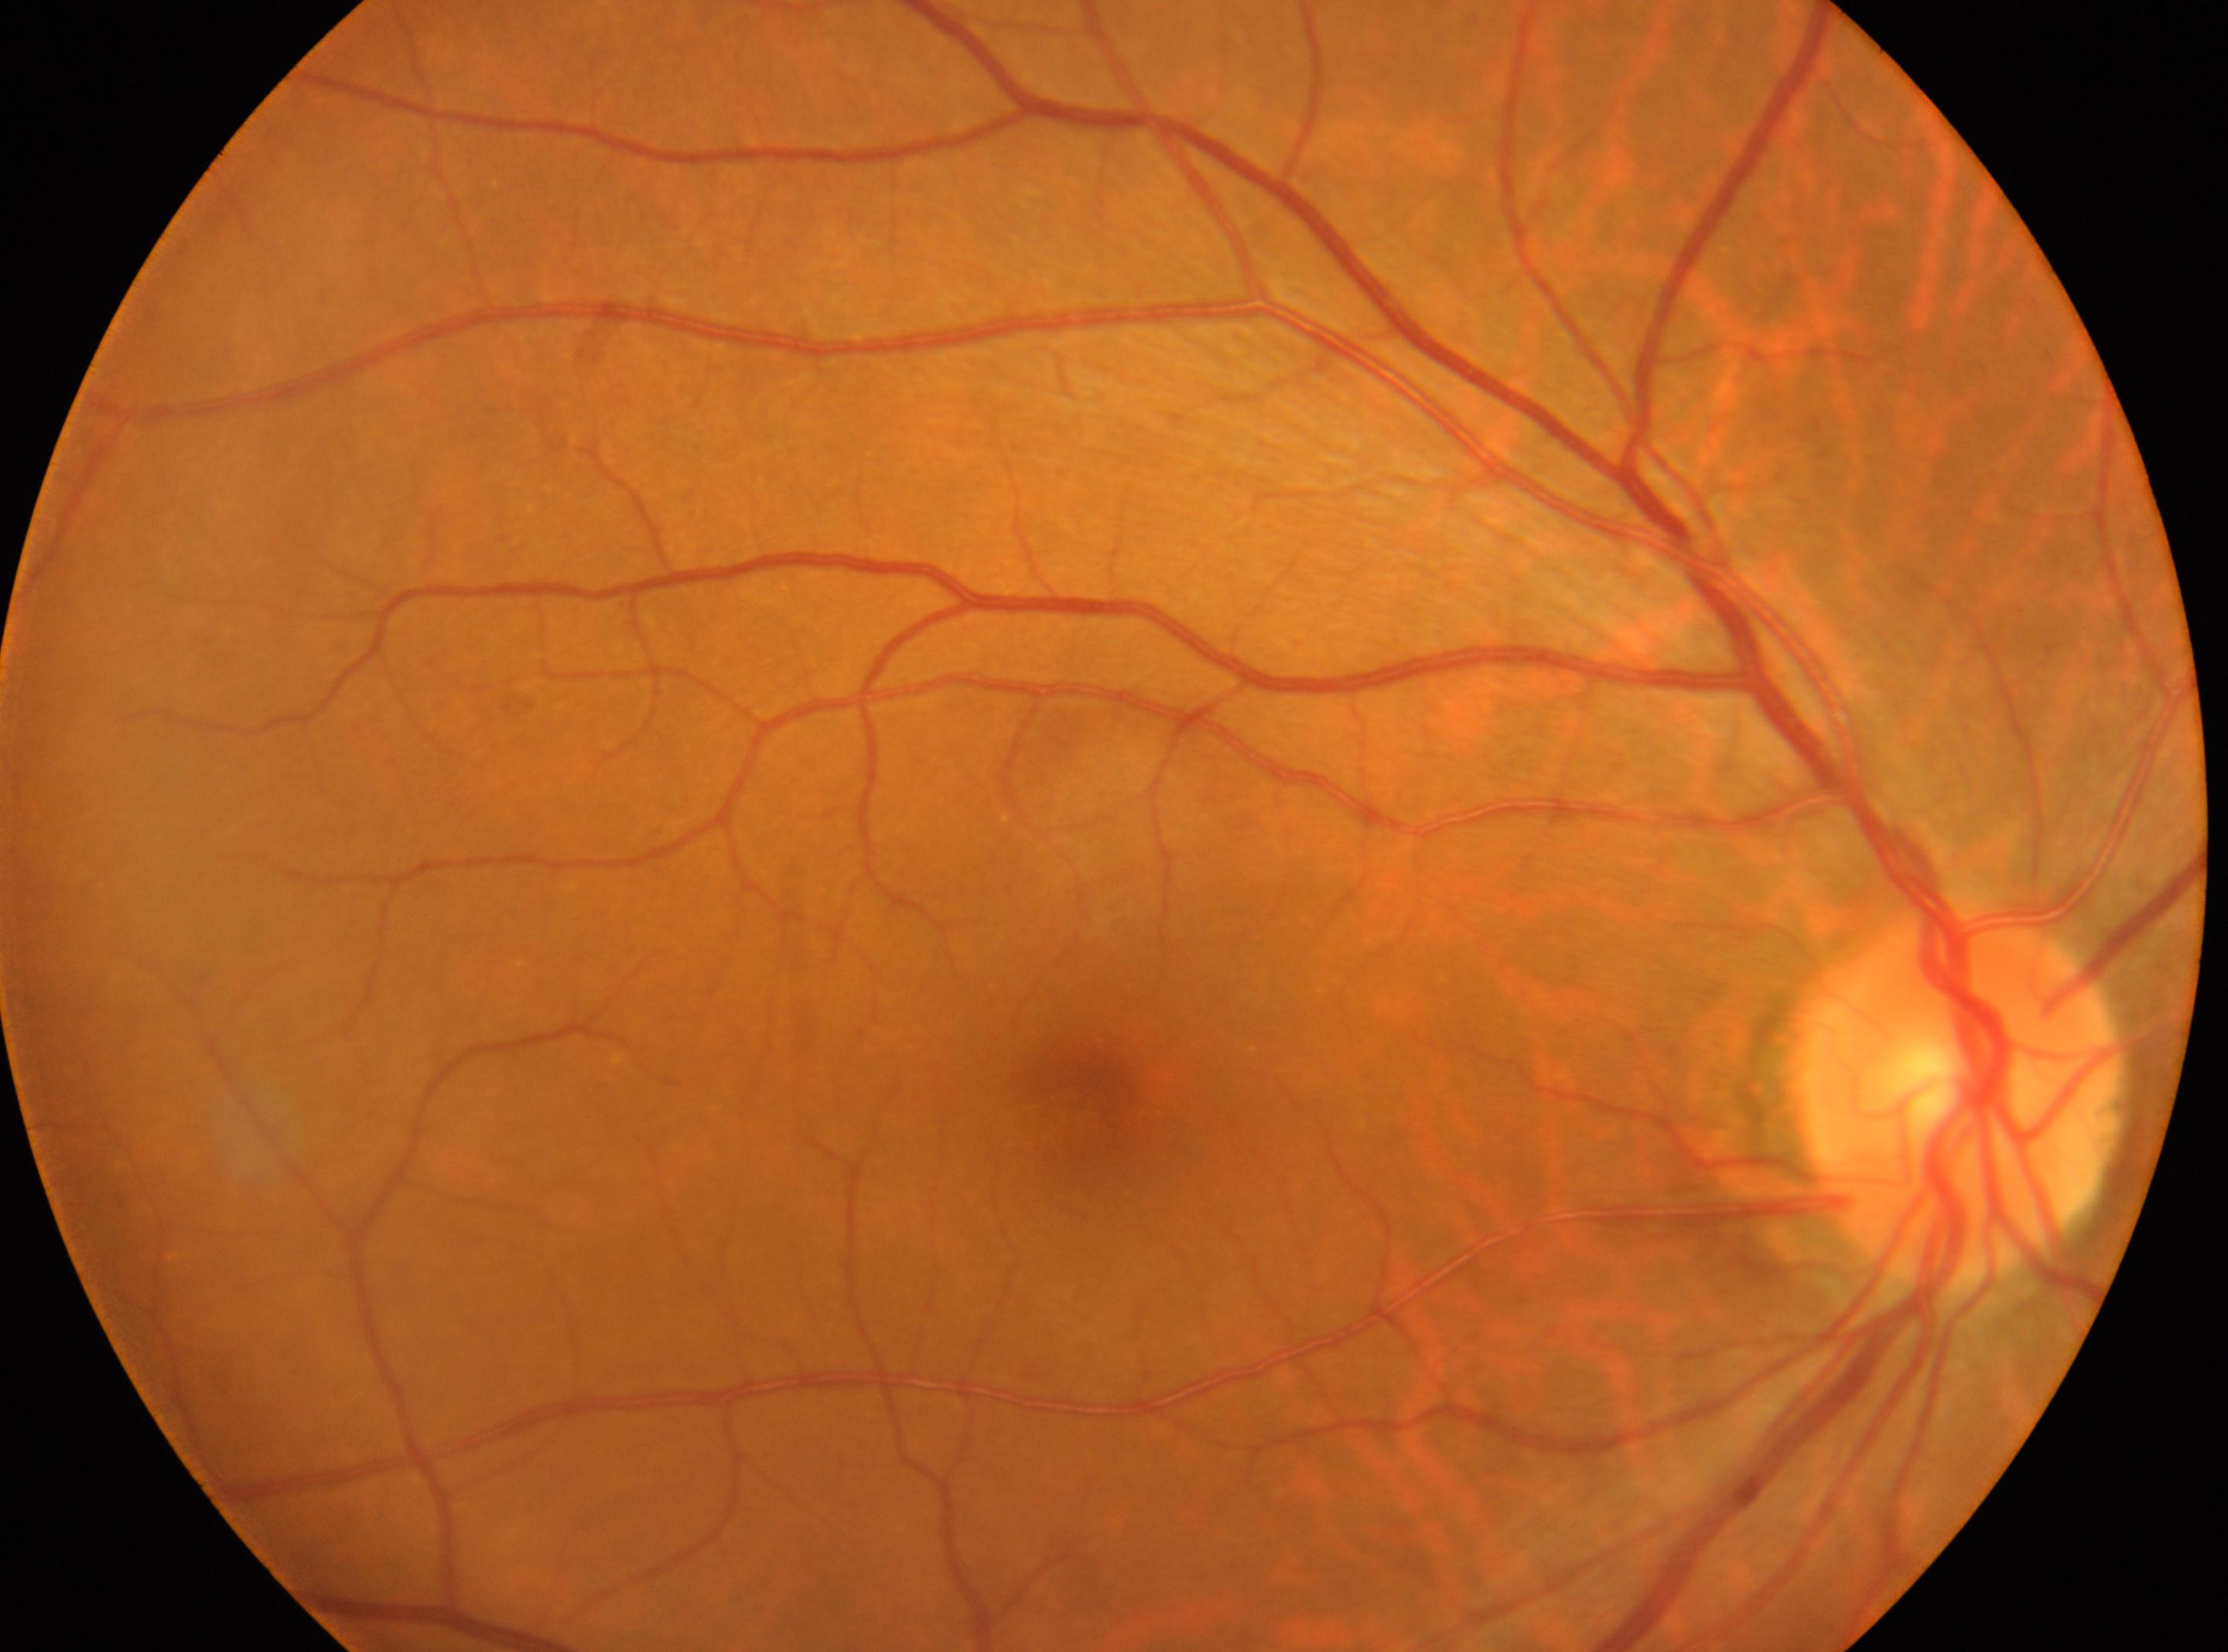 | feature | annotation |
|---|---|
| fovea | (1088,1086) |
| optic disc | (1957,1094) |
| laterality | right eye |
| DR impression | No DR findings |
| retinopathy | no apparent retinopathy (grade 0) |